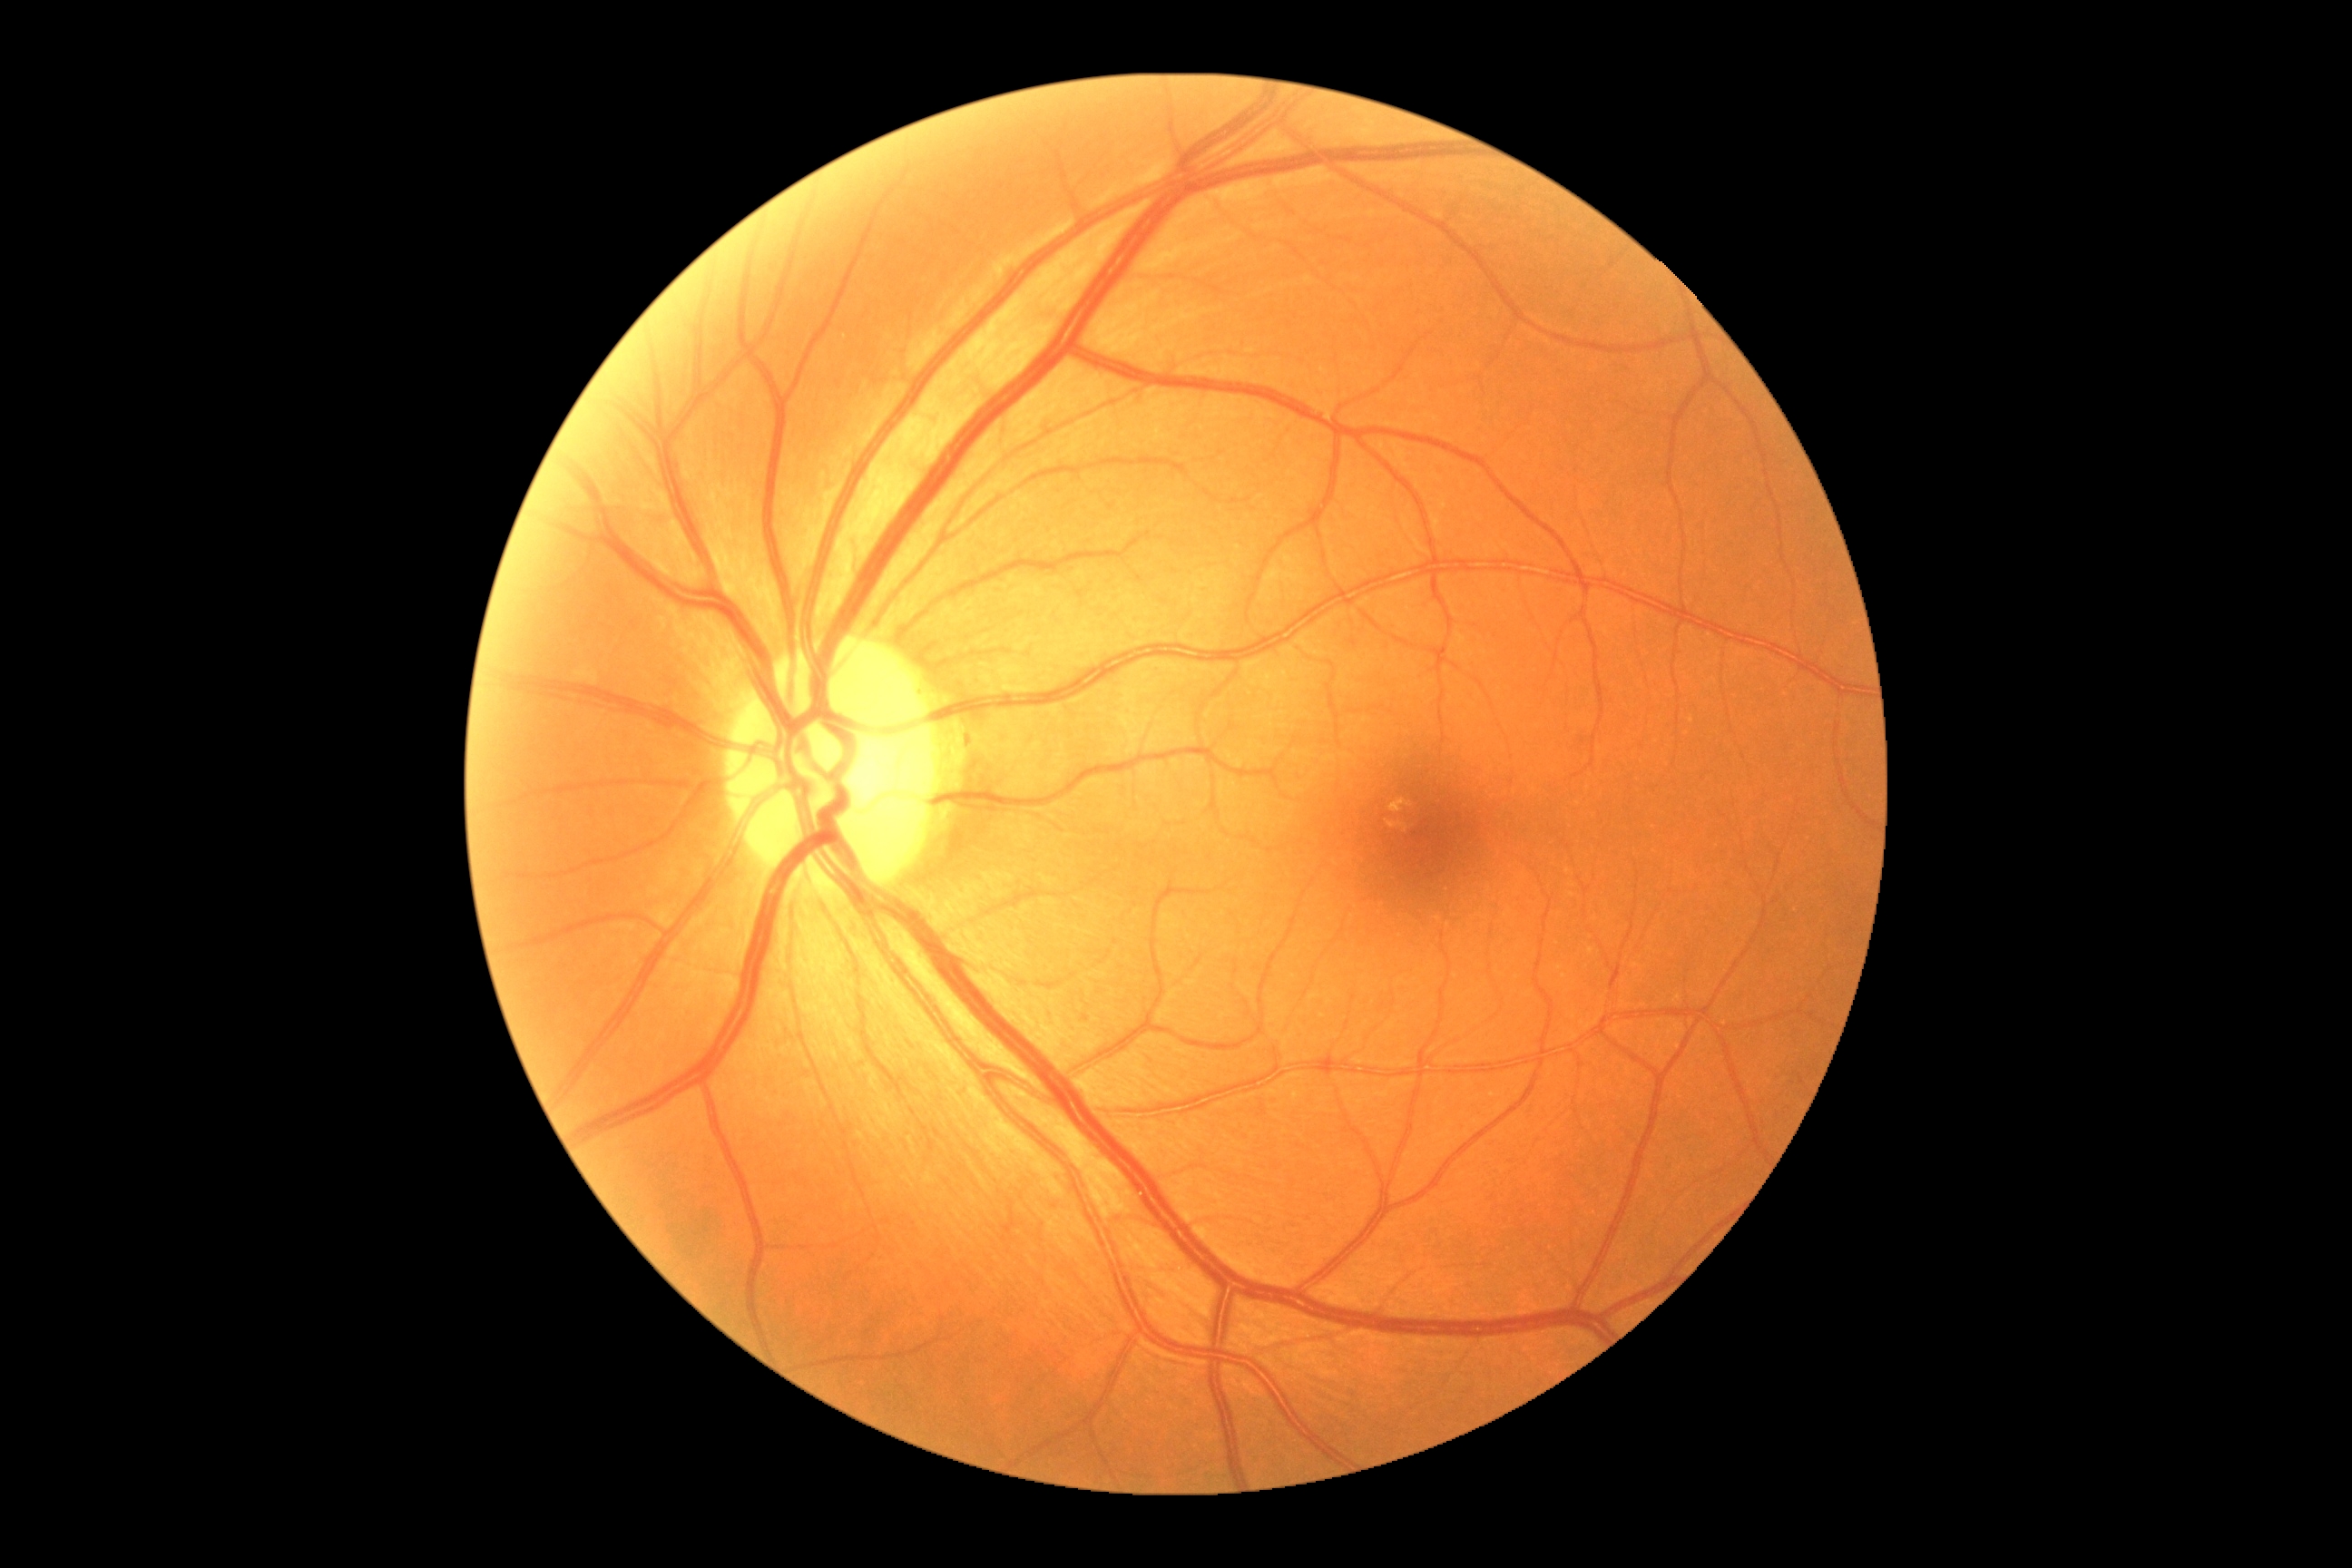
DR impression=negative for DR; diabetic retinopathy (DR)=no apparent diabetic retinopathy (grade 0).